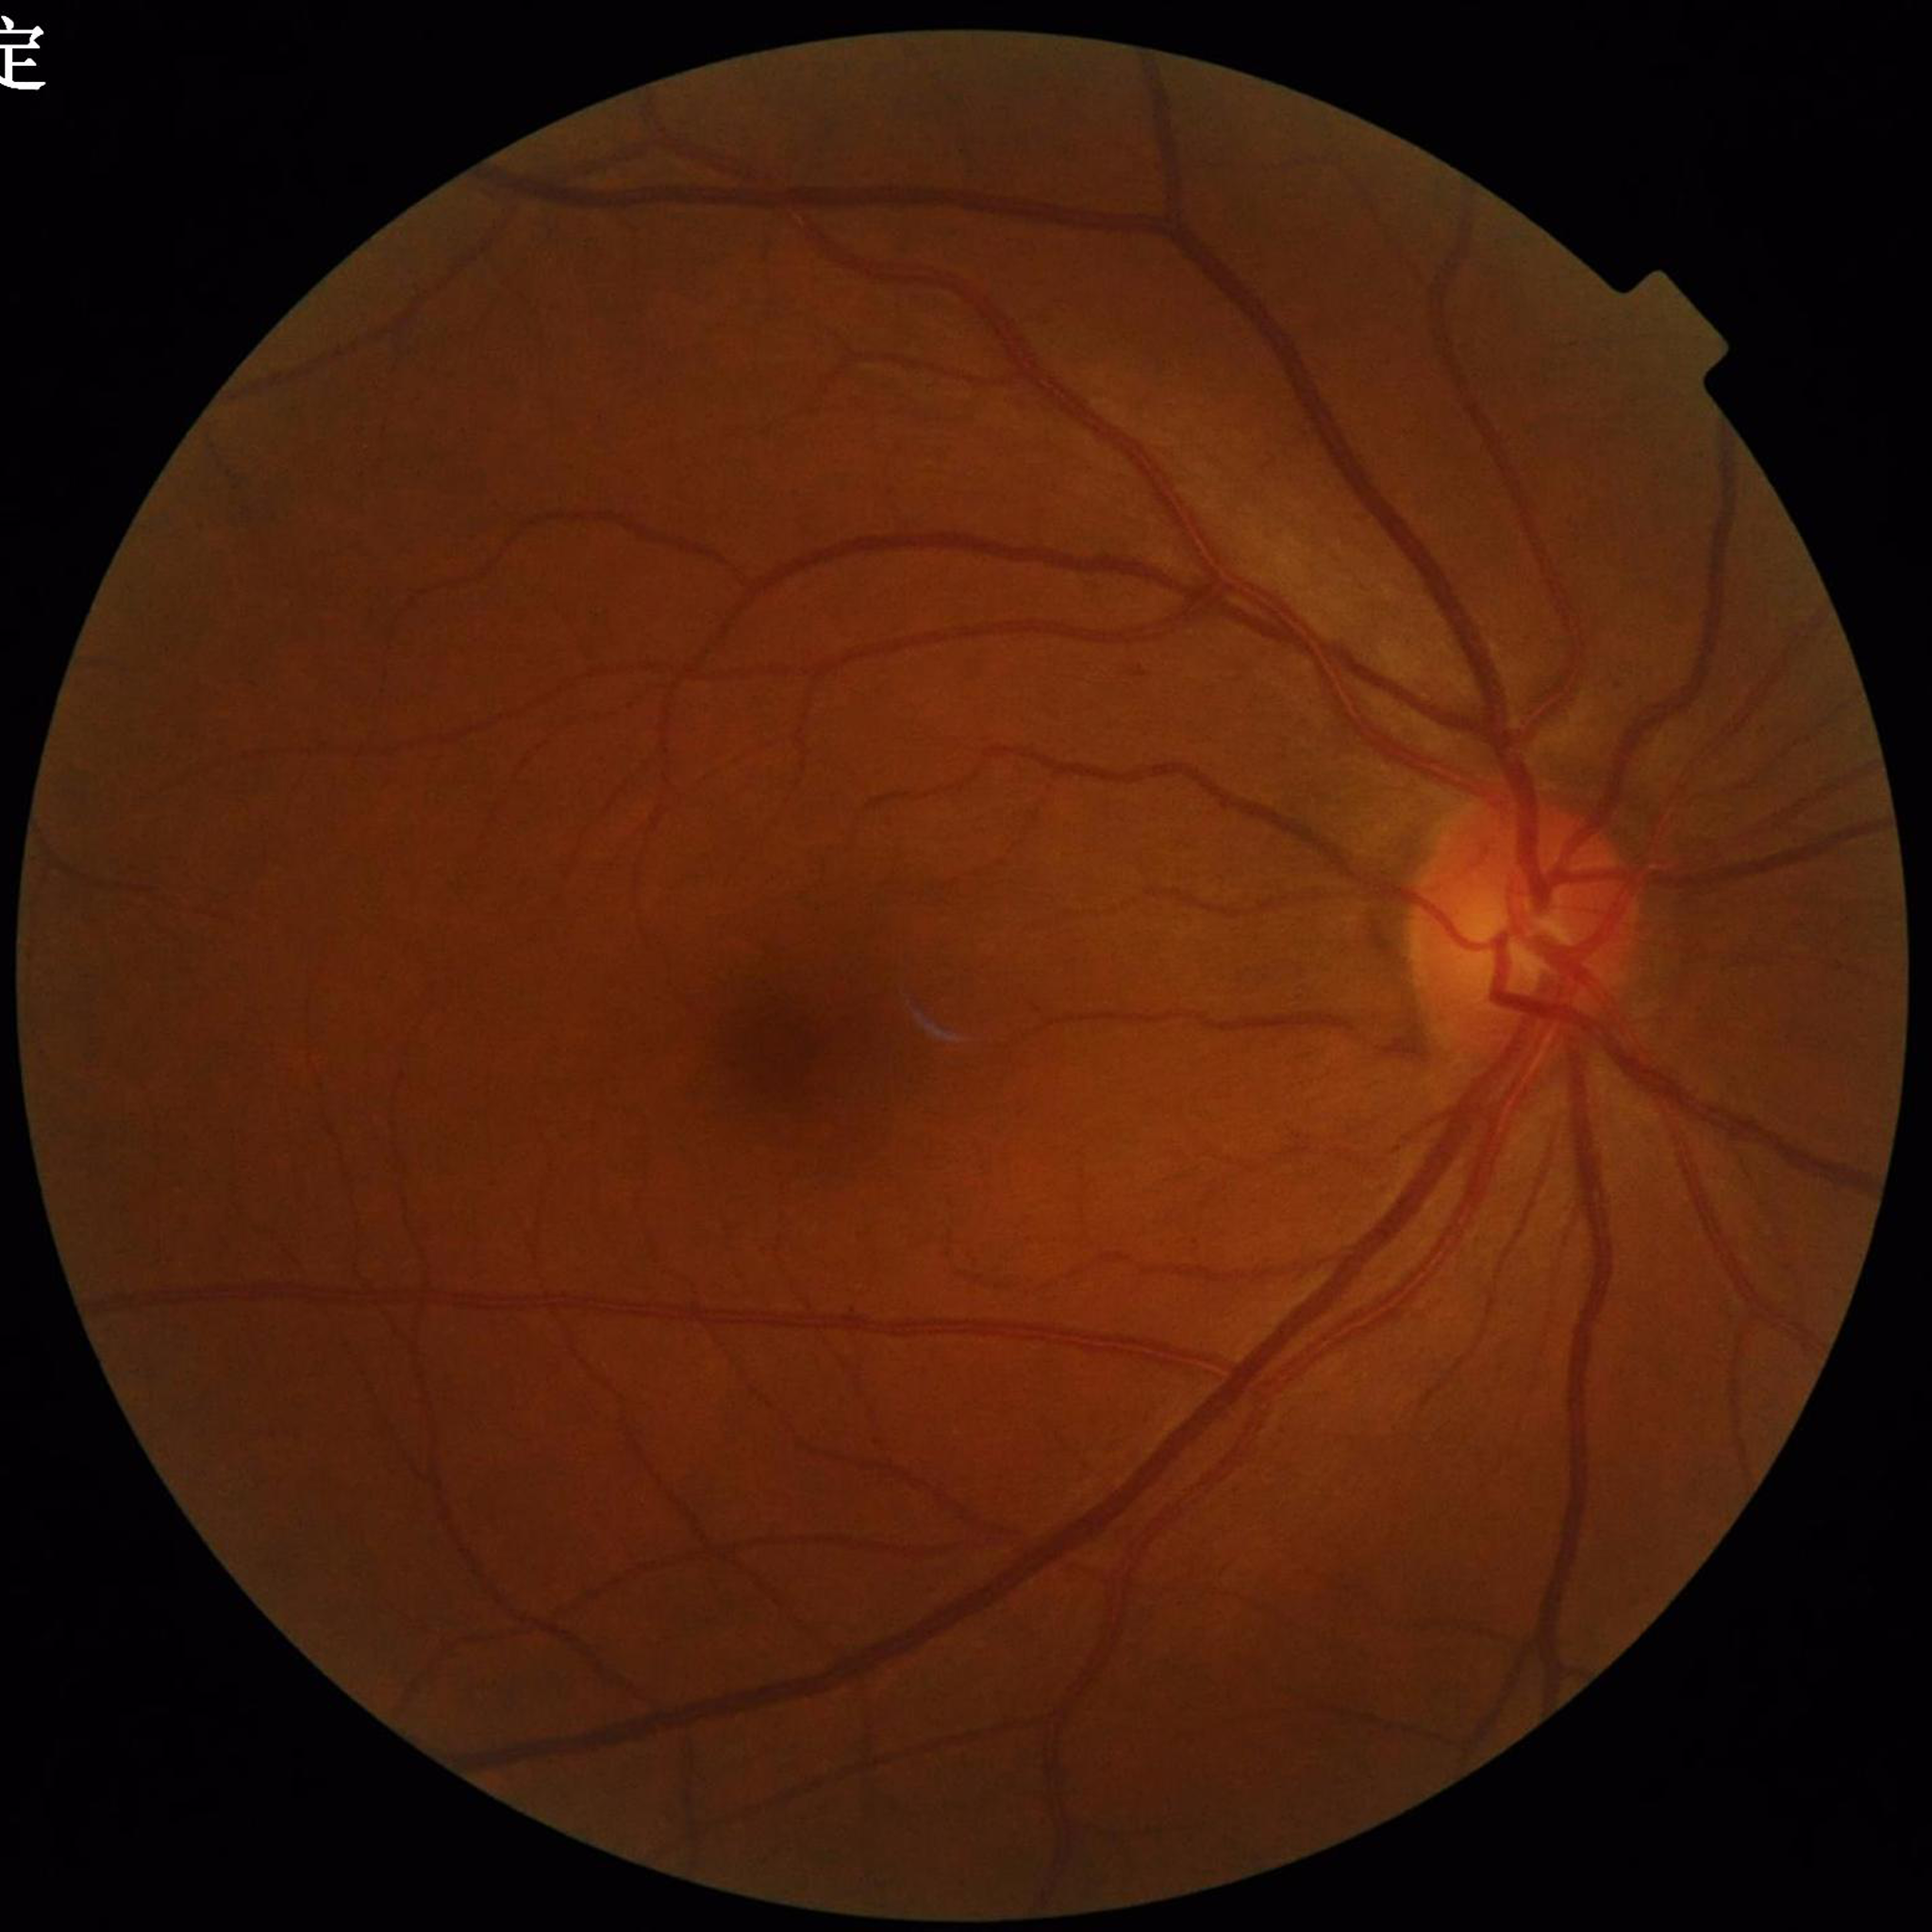

This fundus photograph is from a patient diagnosed with diabetic retinopathy (DR). Image quality: contrast adequate, illumination and color satisfactory, no blur.